Pediatric retinal photograph (wide-field); Phoenix ICON, 100° FOV: 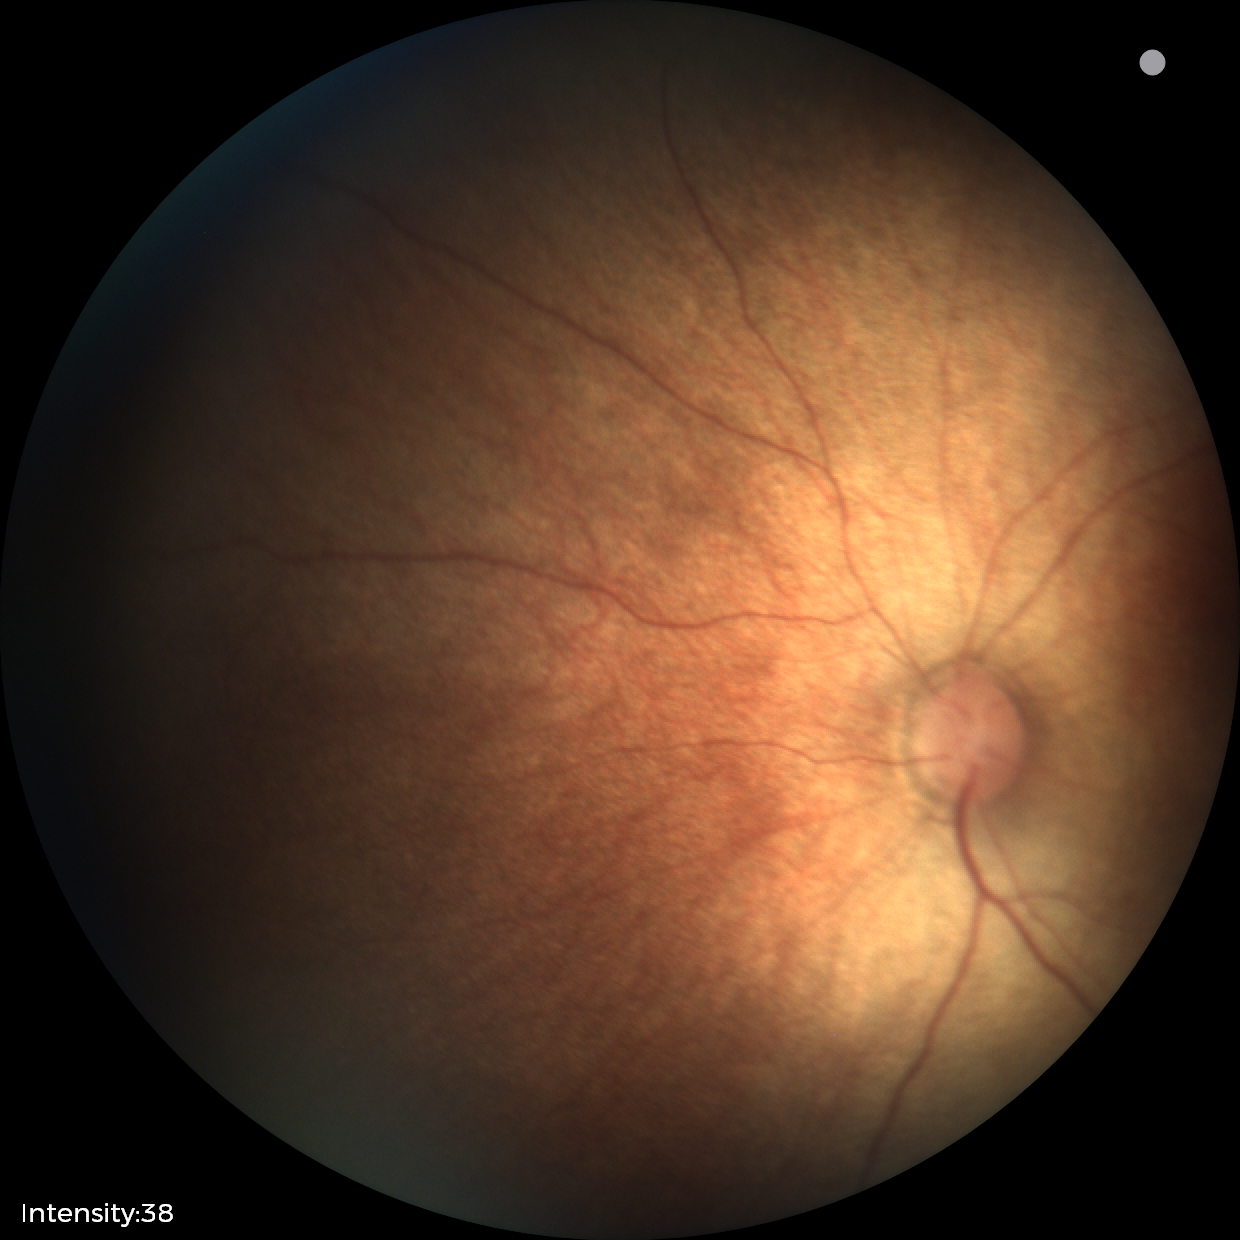

Q: What is the screening diagnosis?
A: no abnormal retinal findings